45-degree field of view
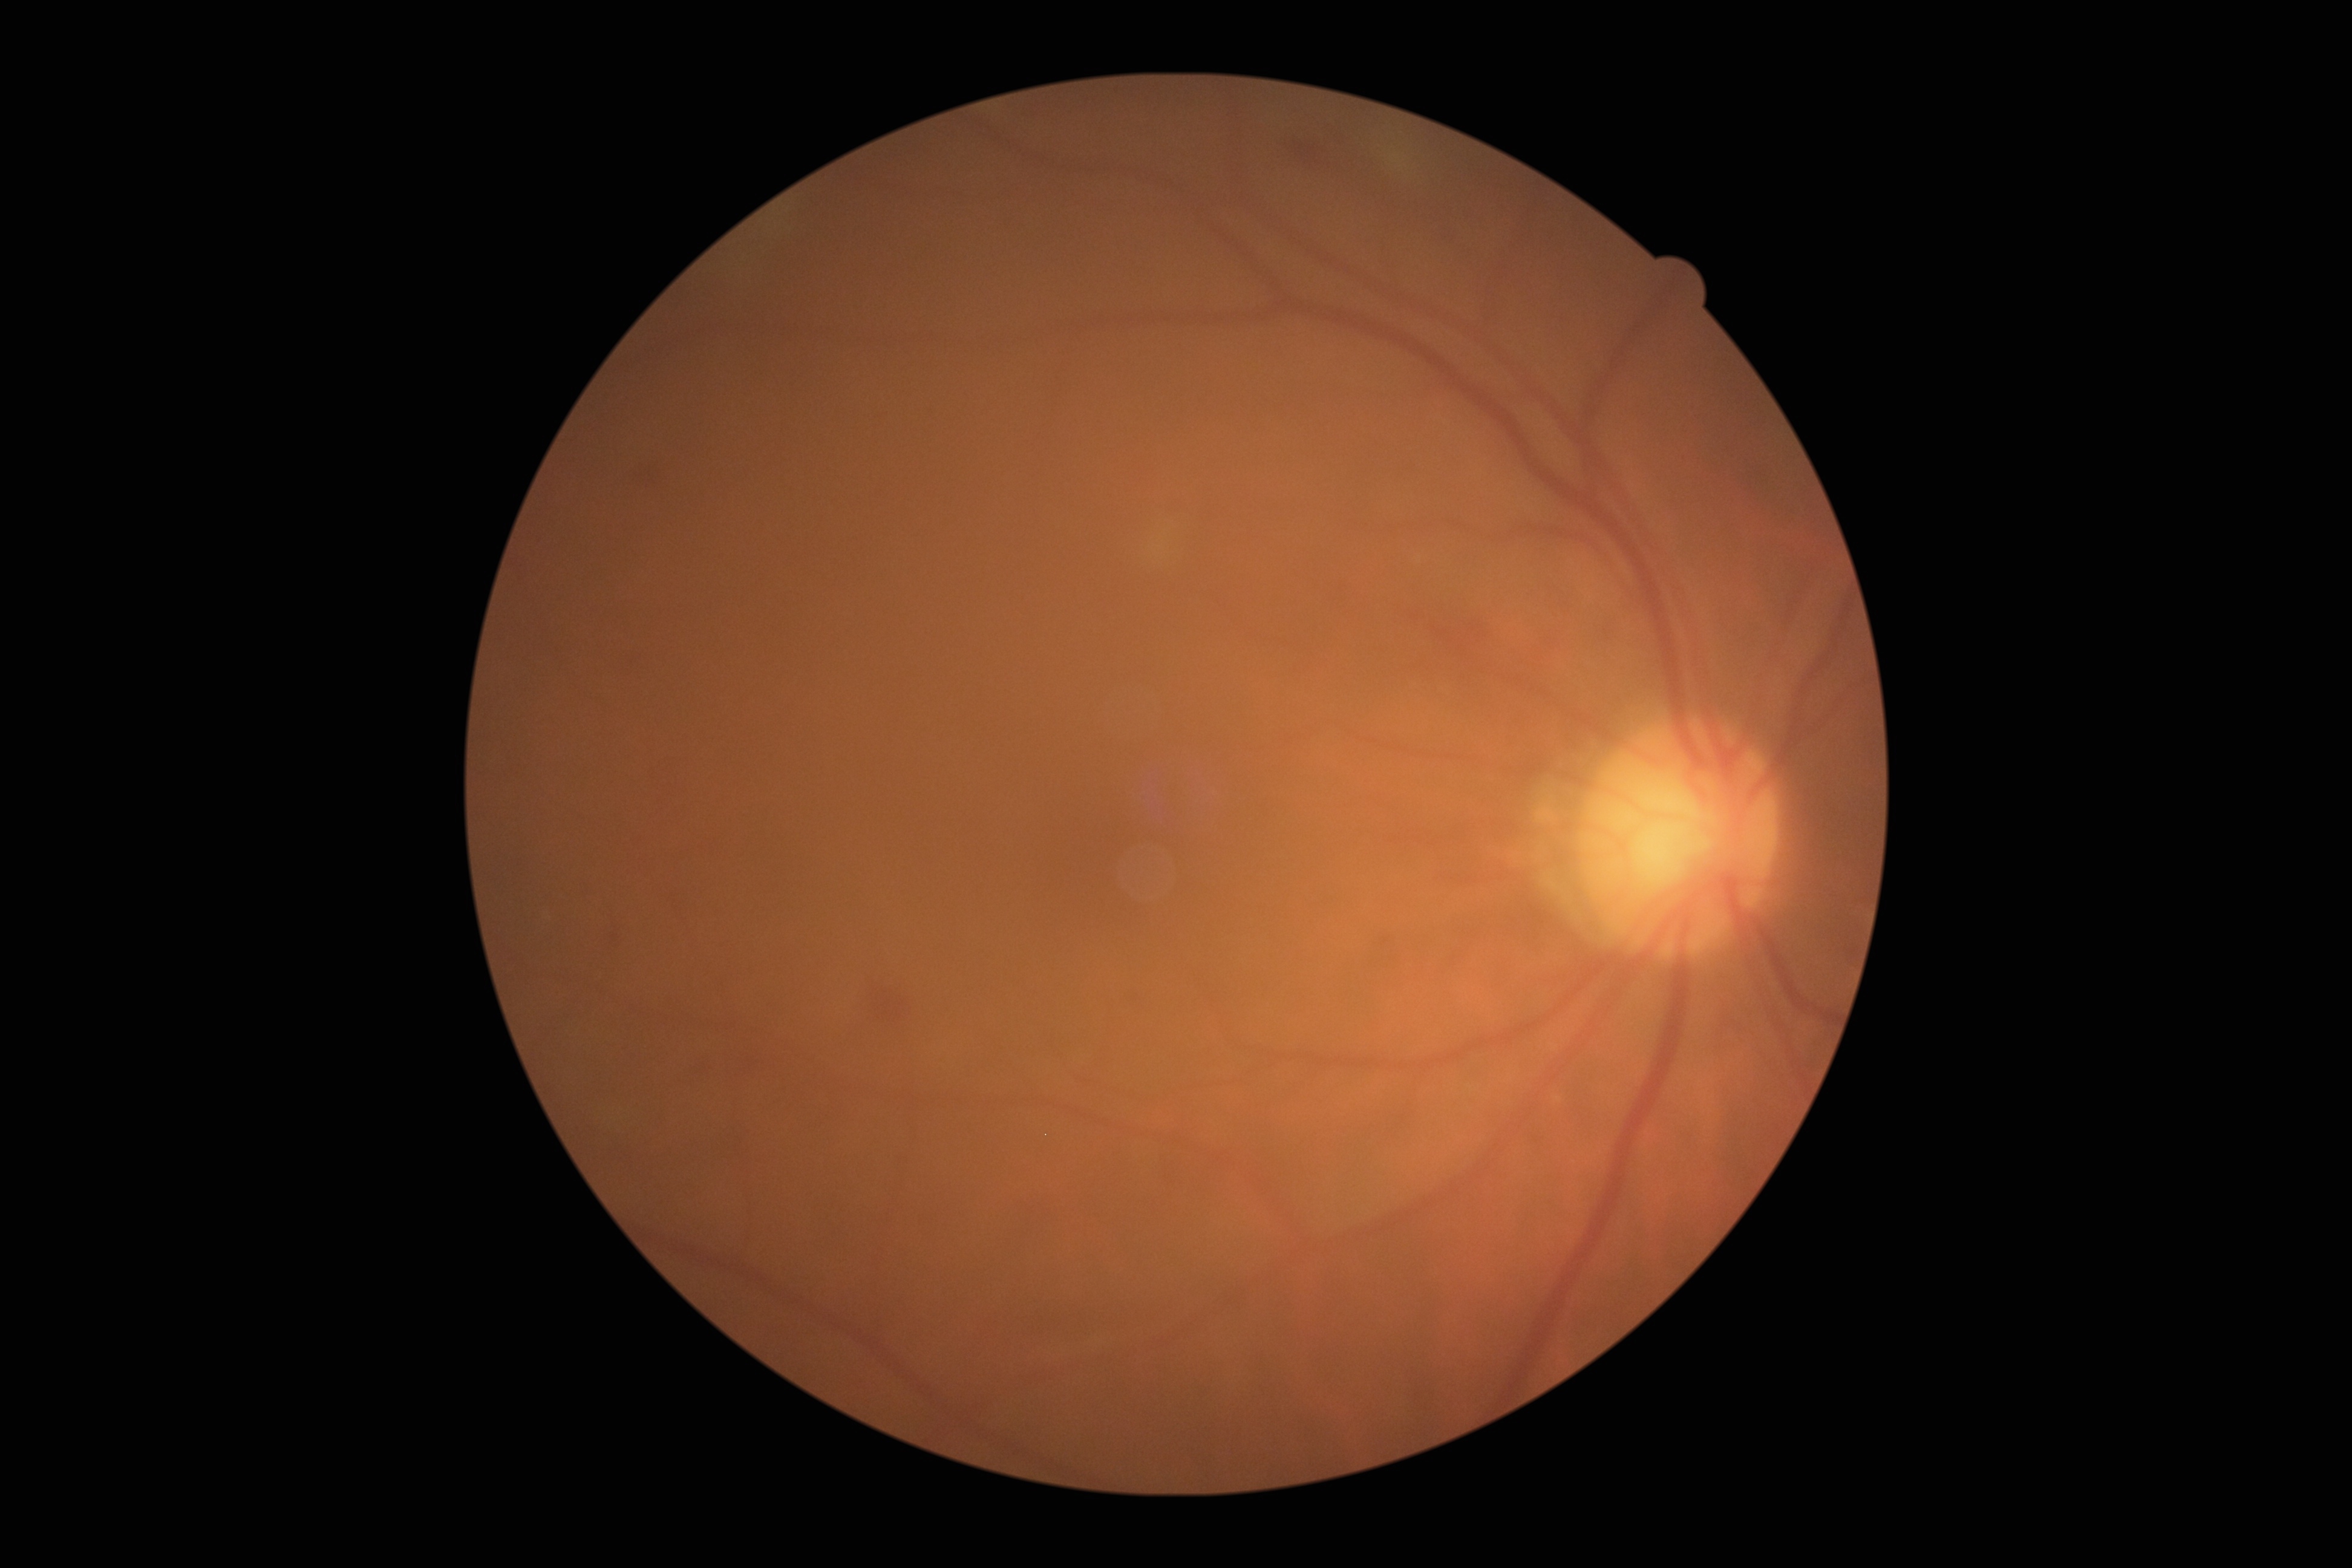 DR stage = moderate non-proliferative diabetic retinopathy (grade 2)